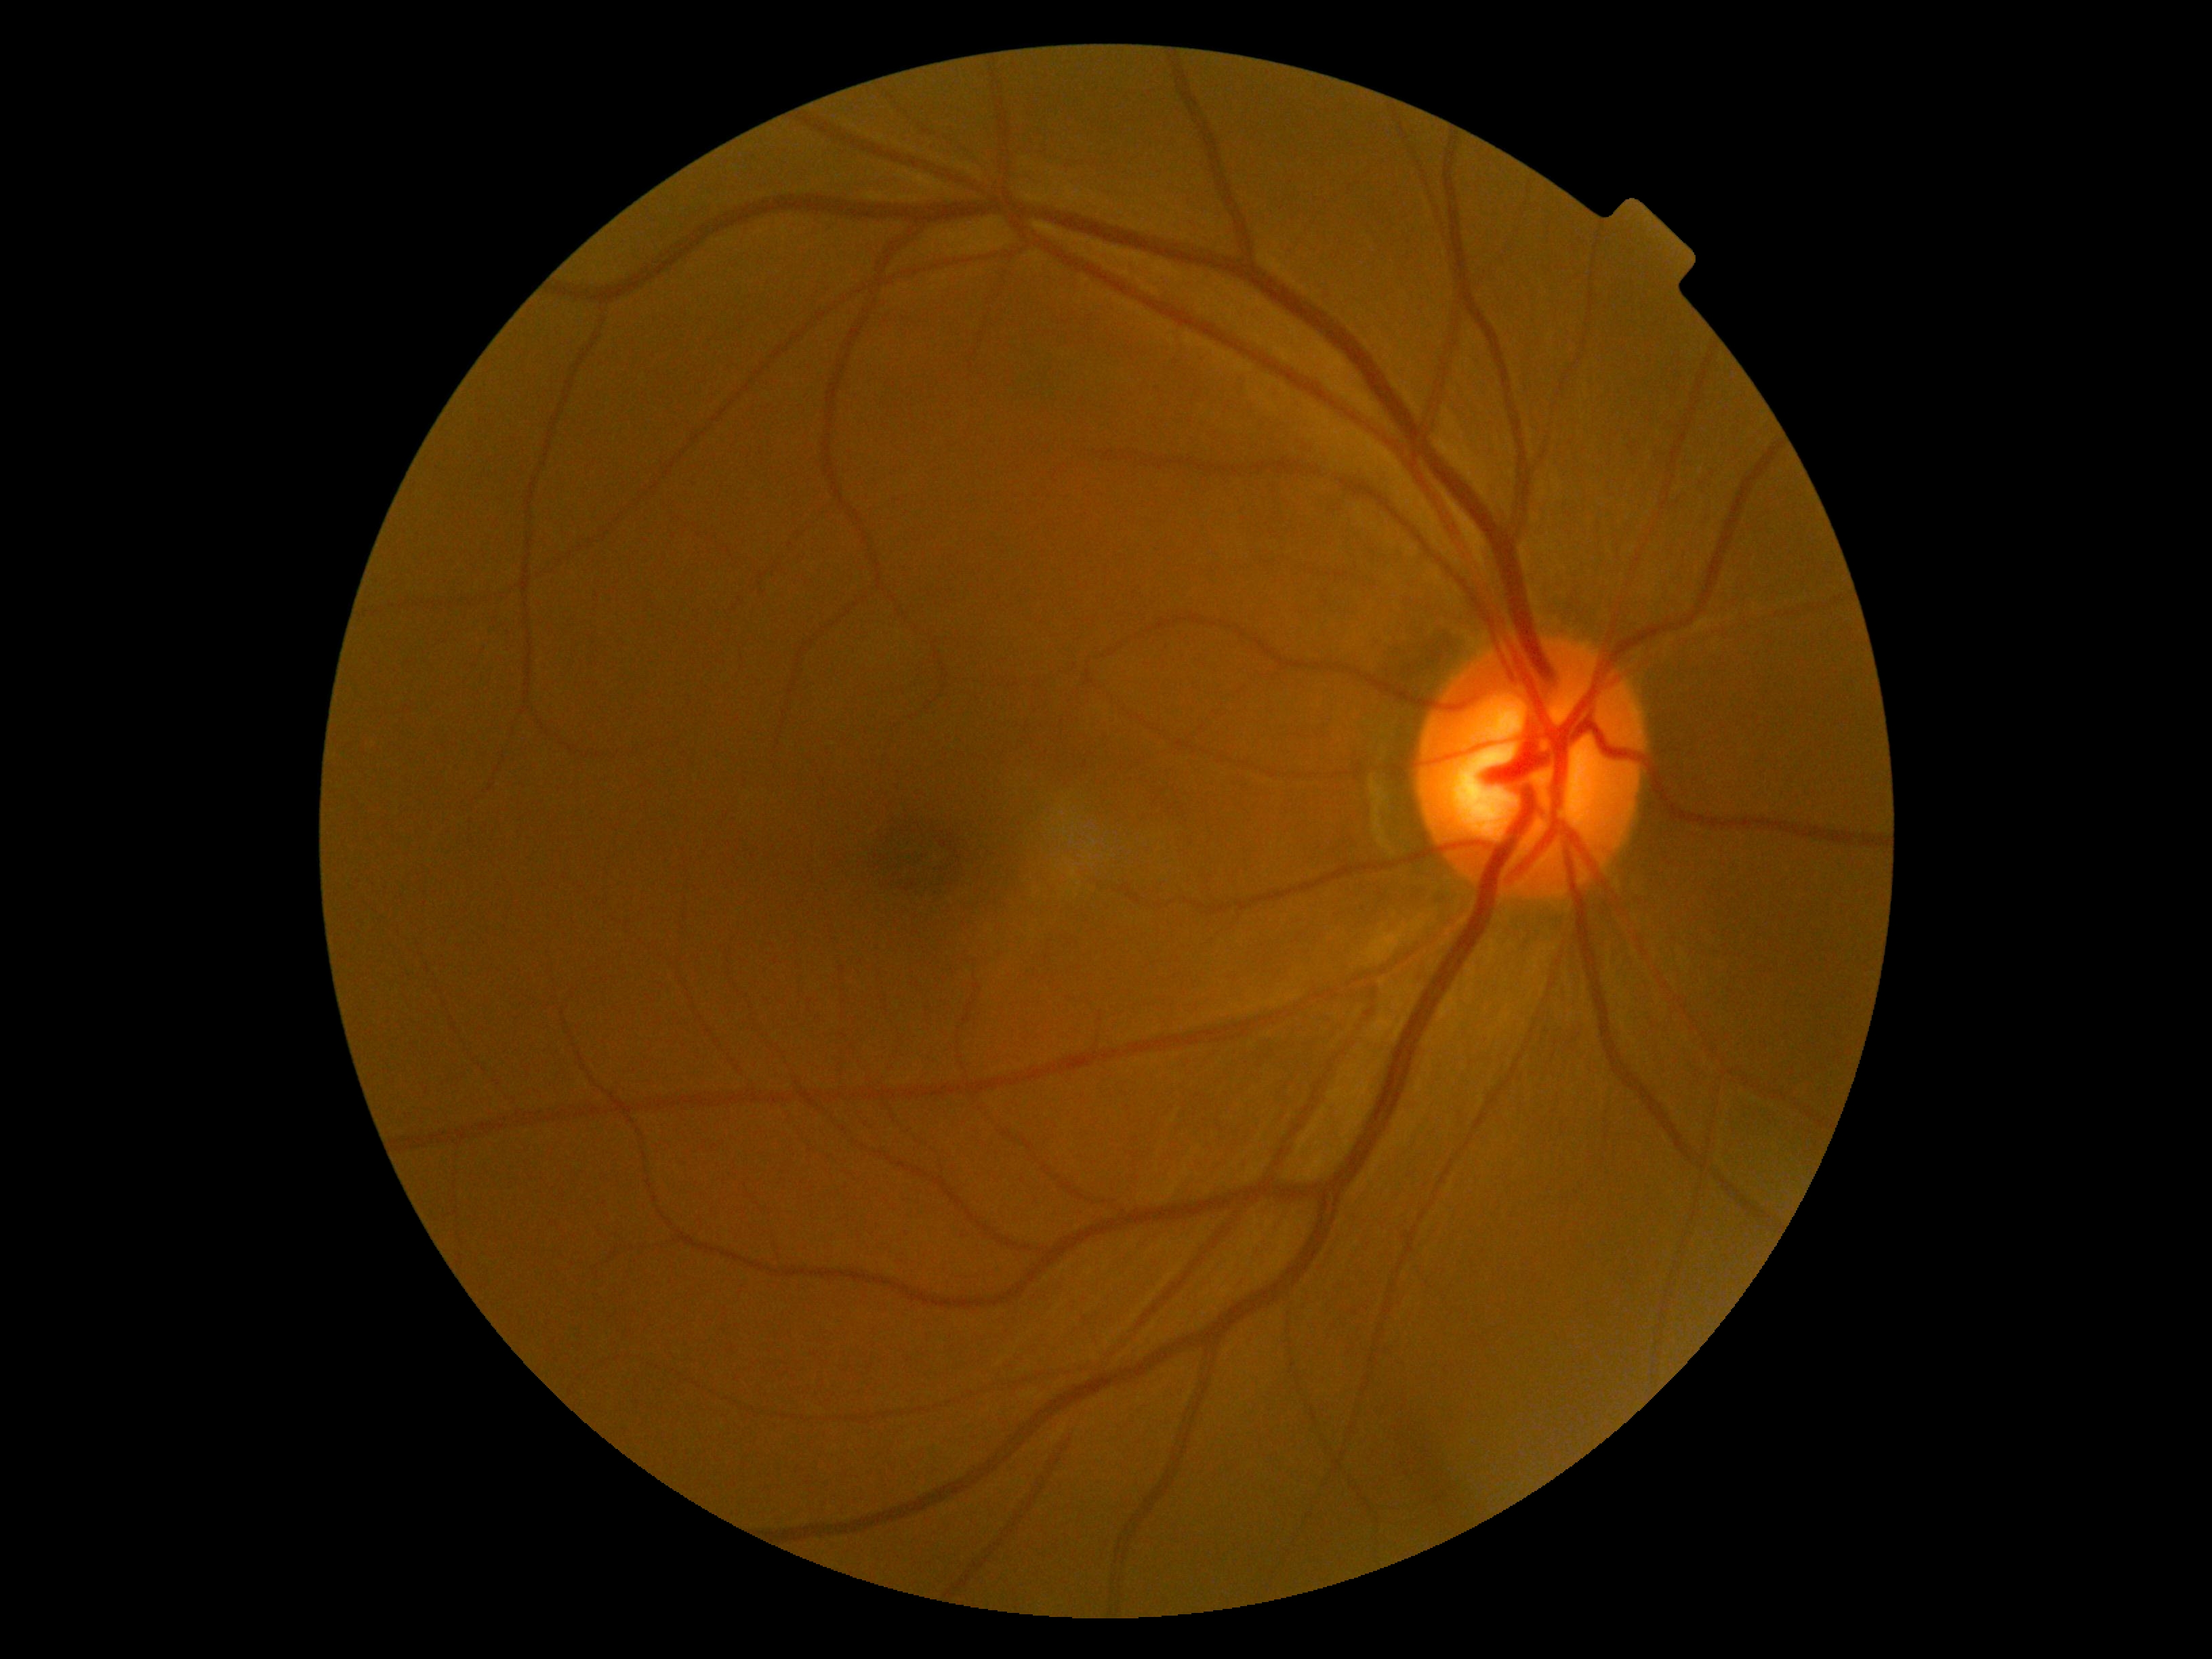

Diabetic retinopathy grade is no apparent retinopathy (0).